1932 by 1910 pixels.
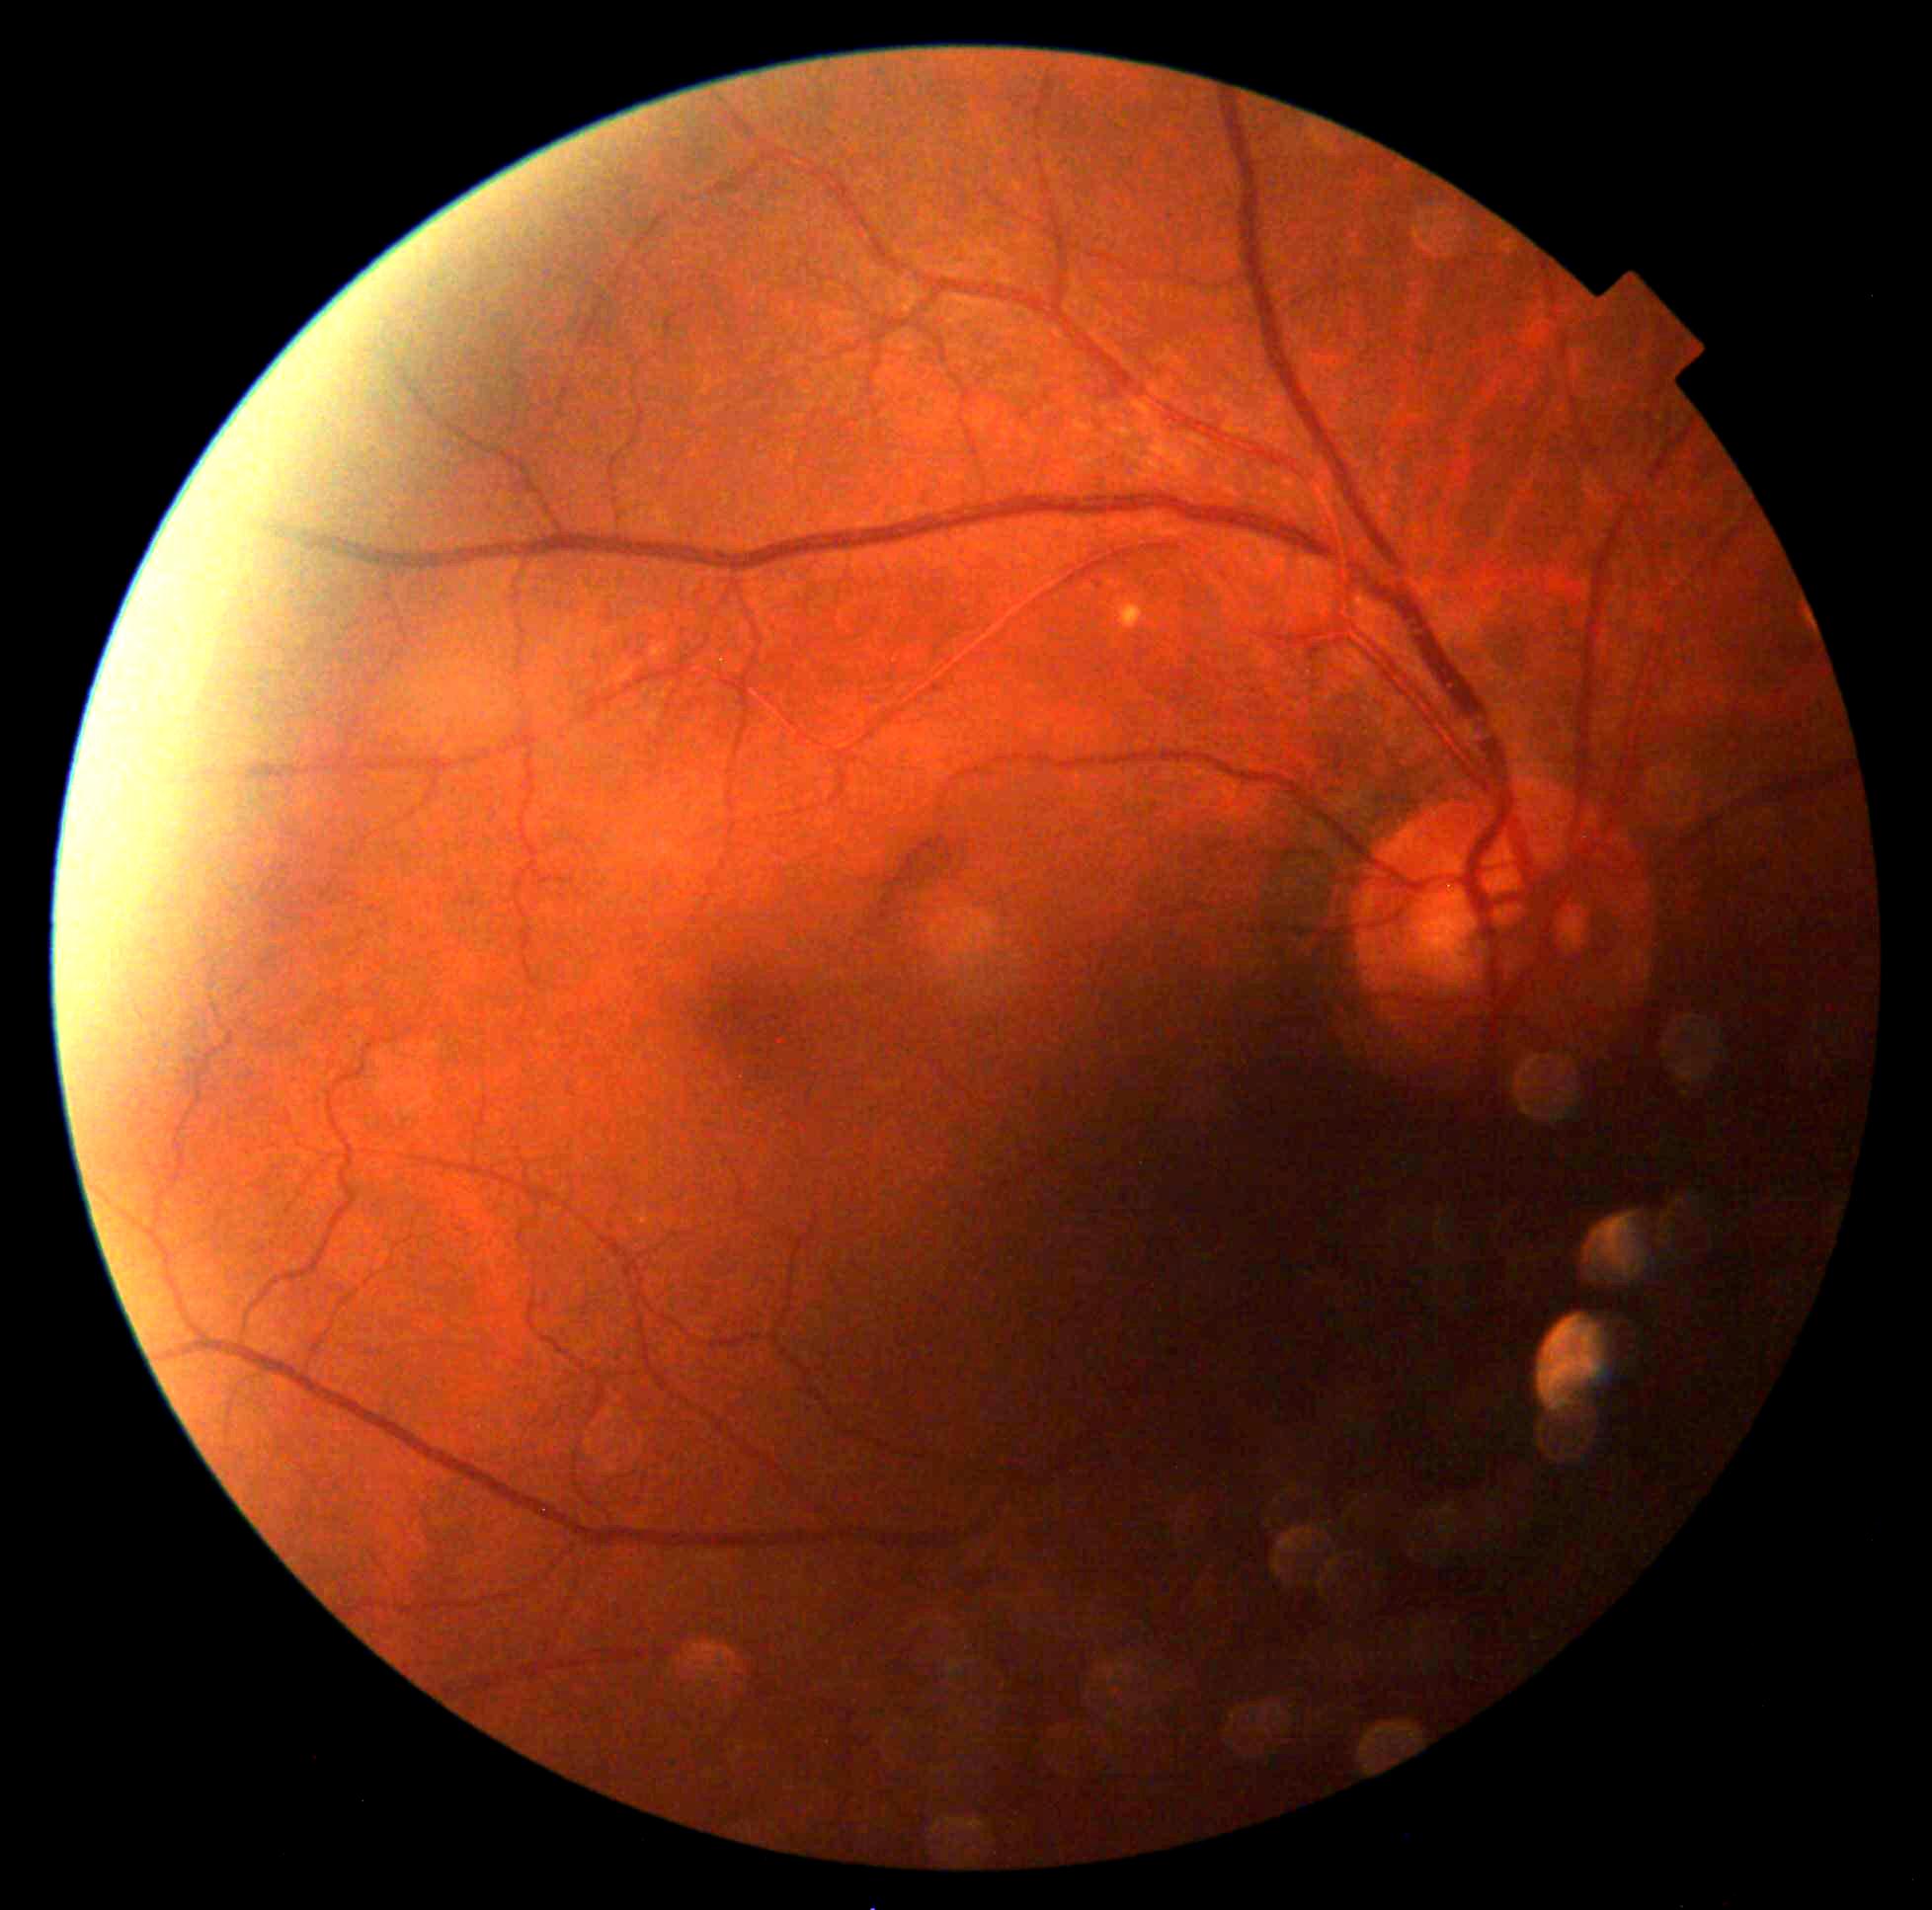
DR grade: 0 — no visible signs of diabetic retinopathy.